Color fundus image; disc-centered field; acquired with a Nidek AFC-330
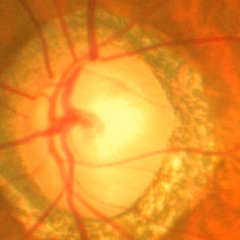 Glaucoma status = advanced glaucomatous optic neuropathy.